45° FOV.
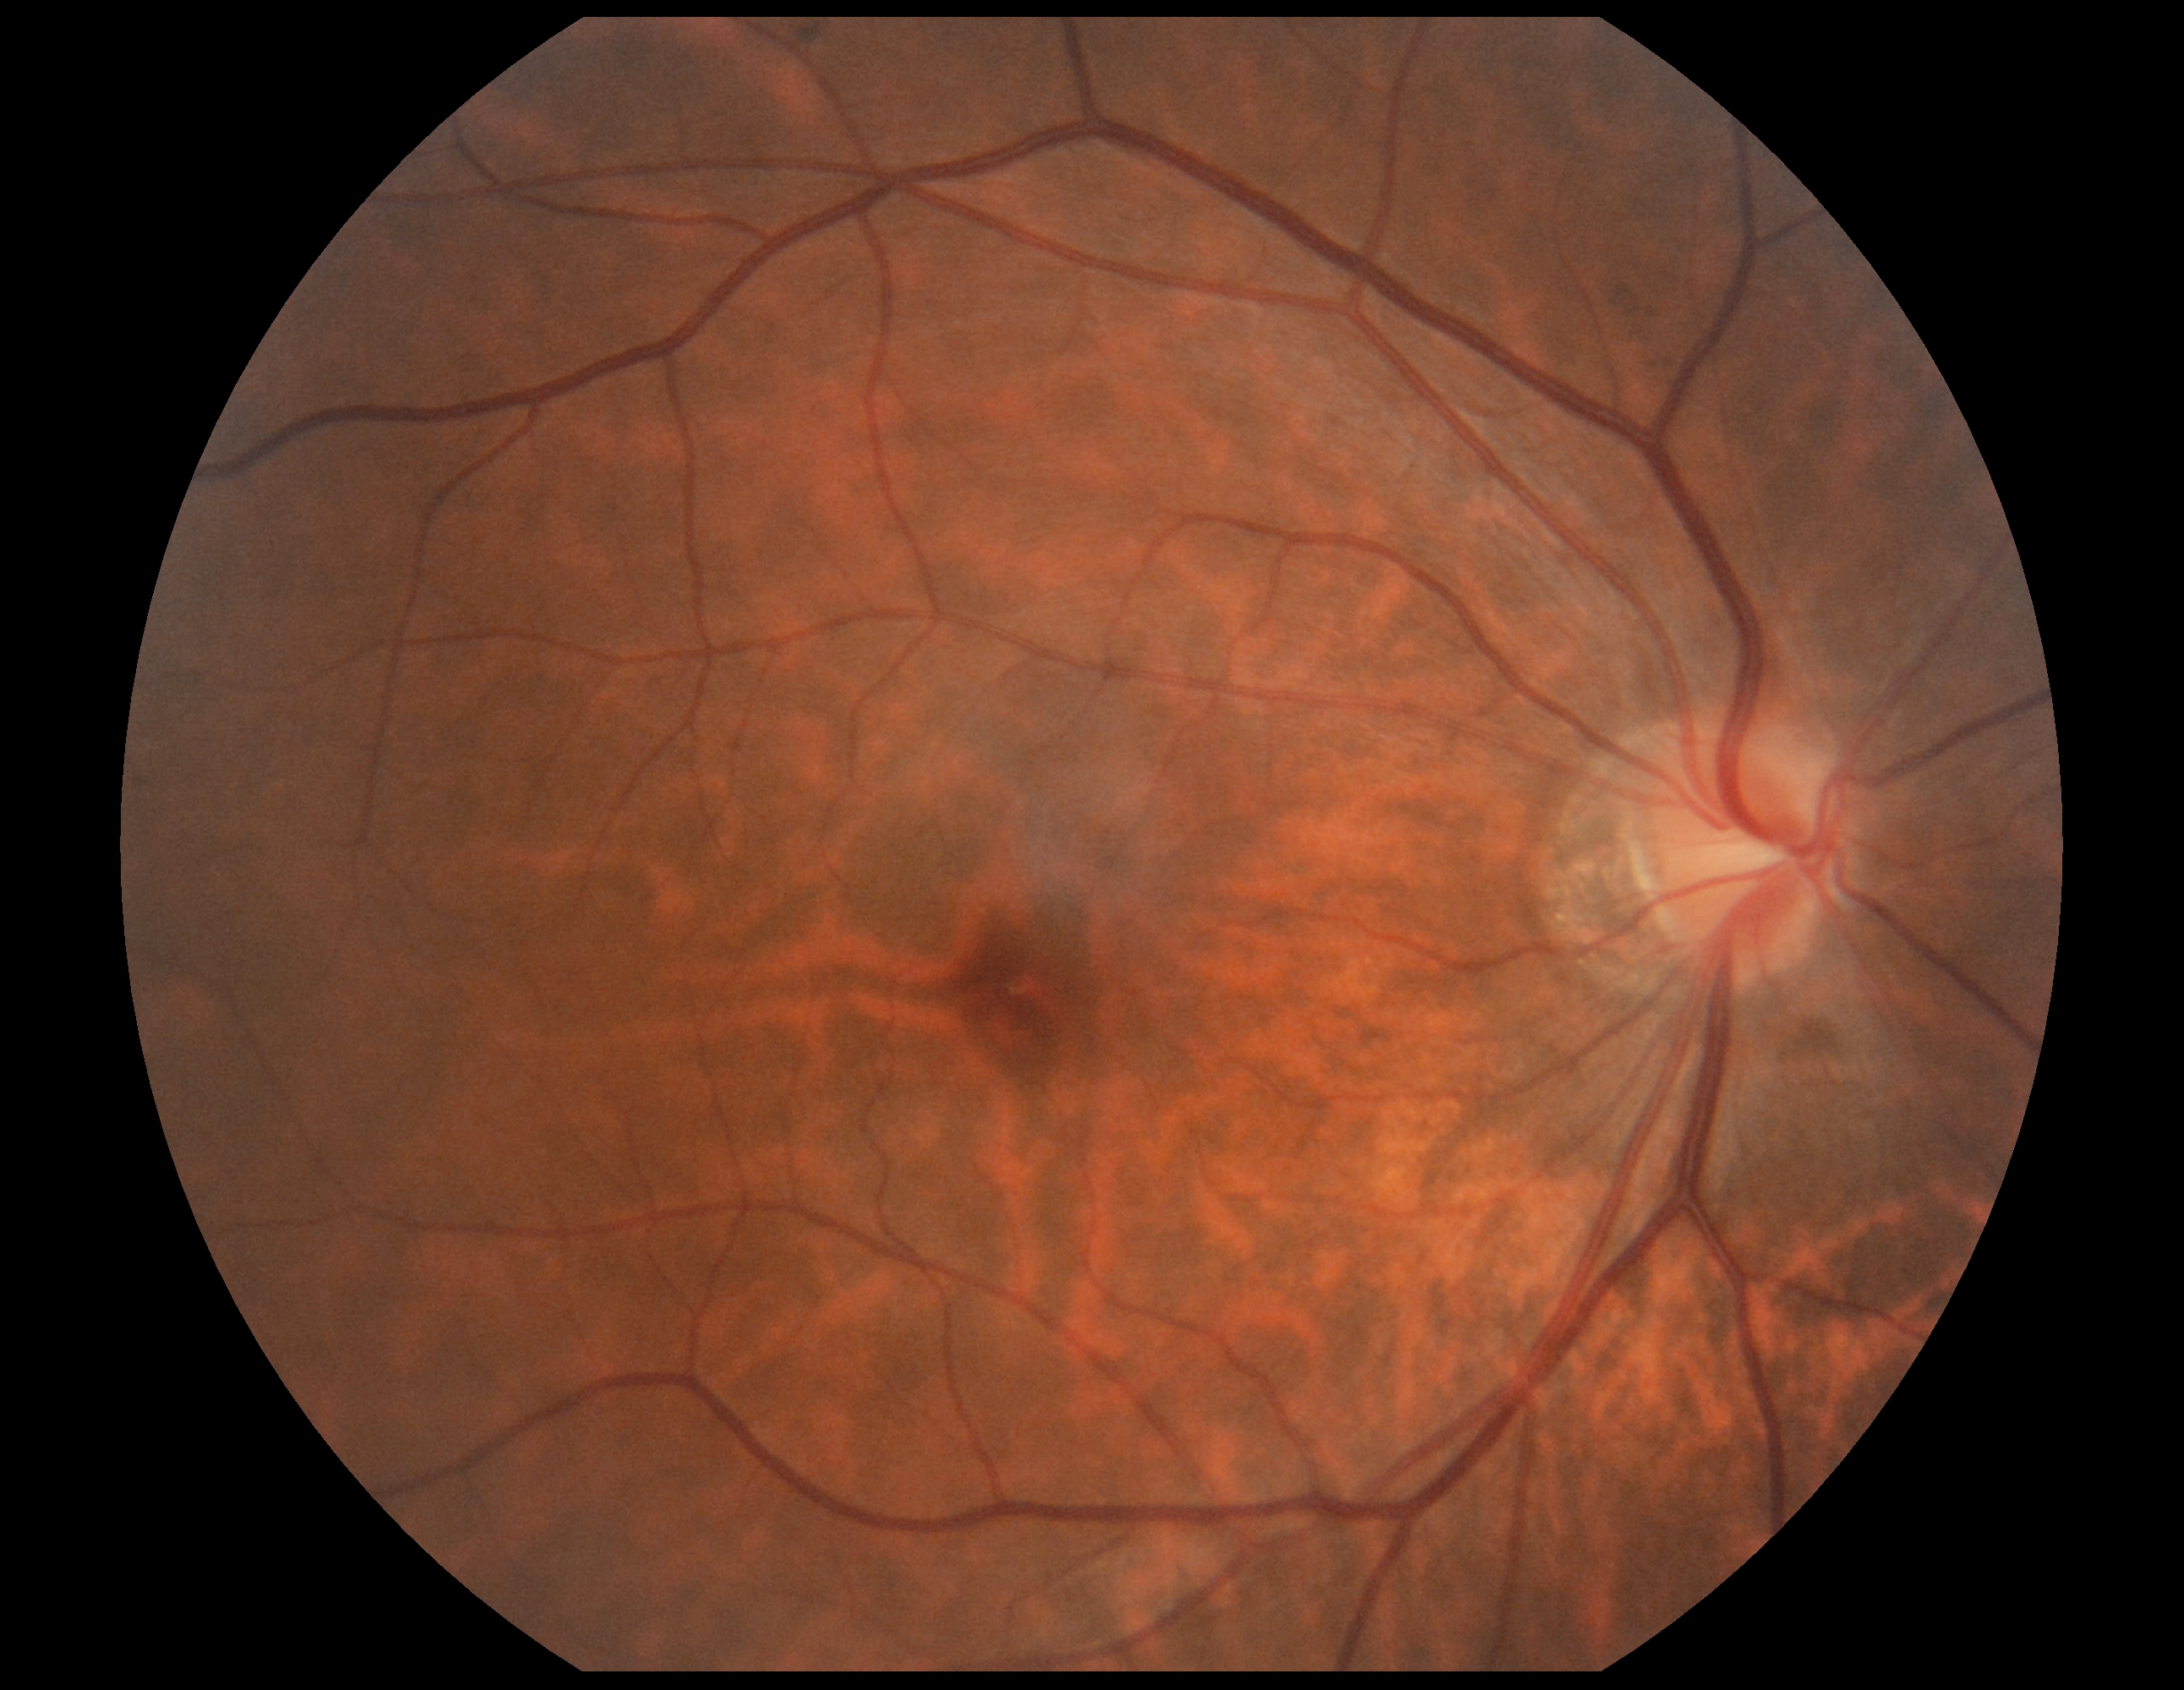 retinopathy: 0; DR impression: no apparent DR.